30-degree field of view; optic disc at the center of the field; IOP (pneumatic tonometry): 12 mmHg; central corneal thickness: 500 µm; undilated pupil:
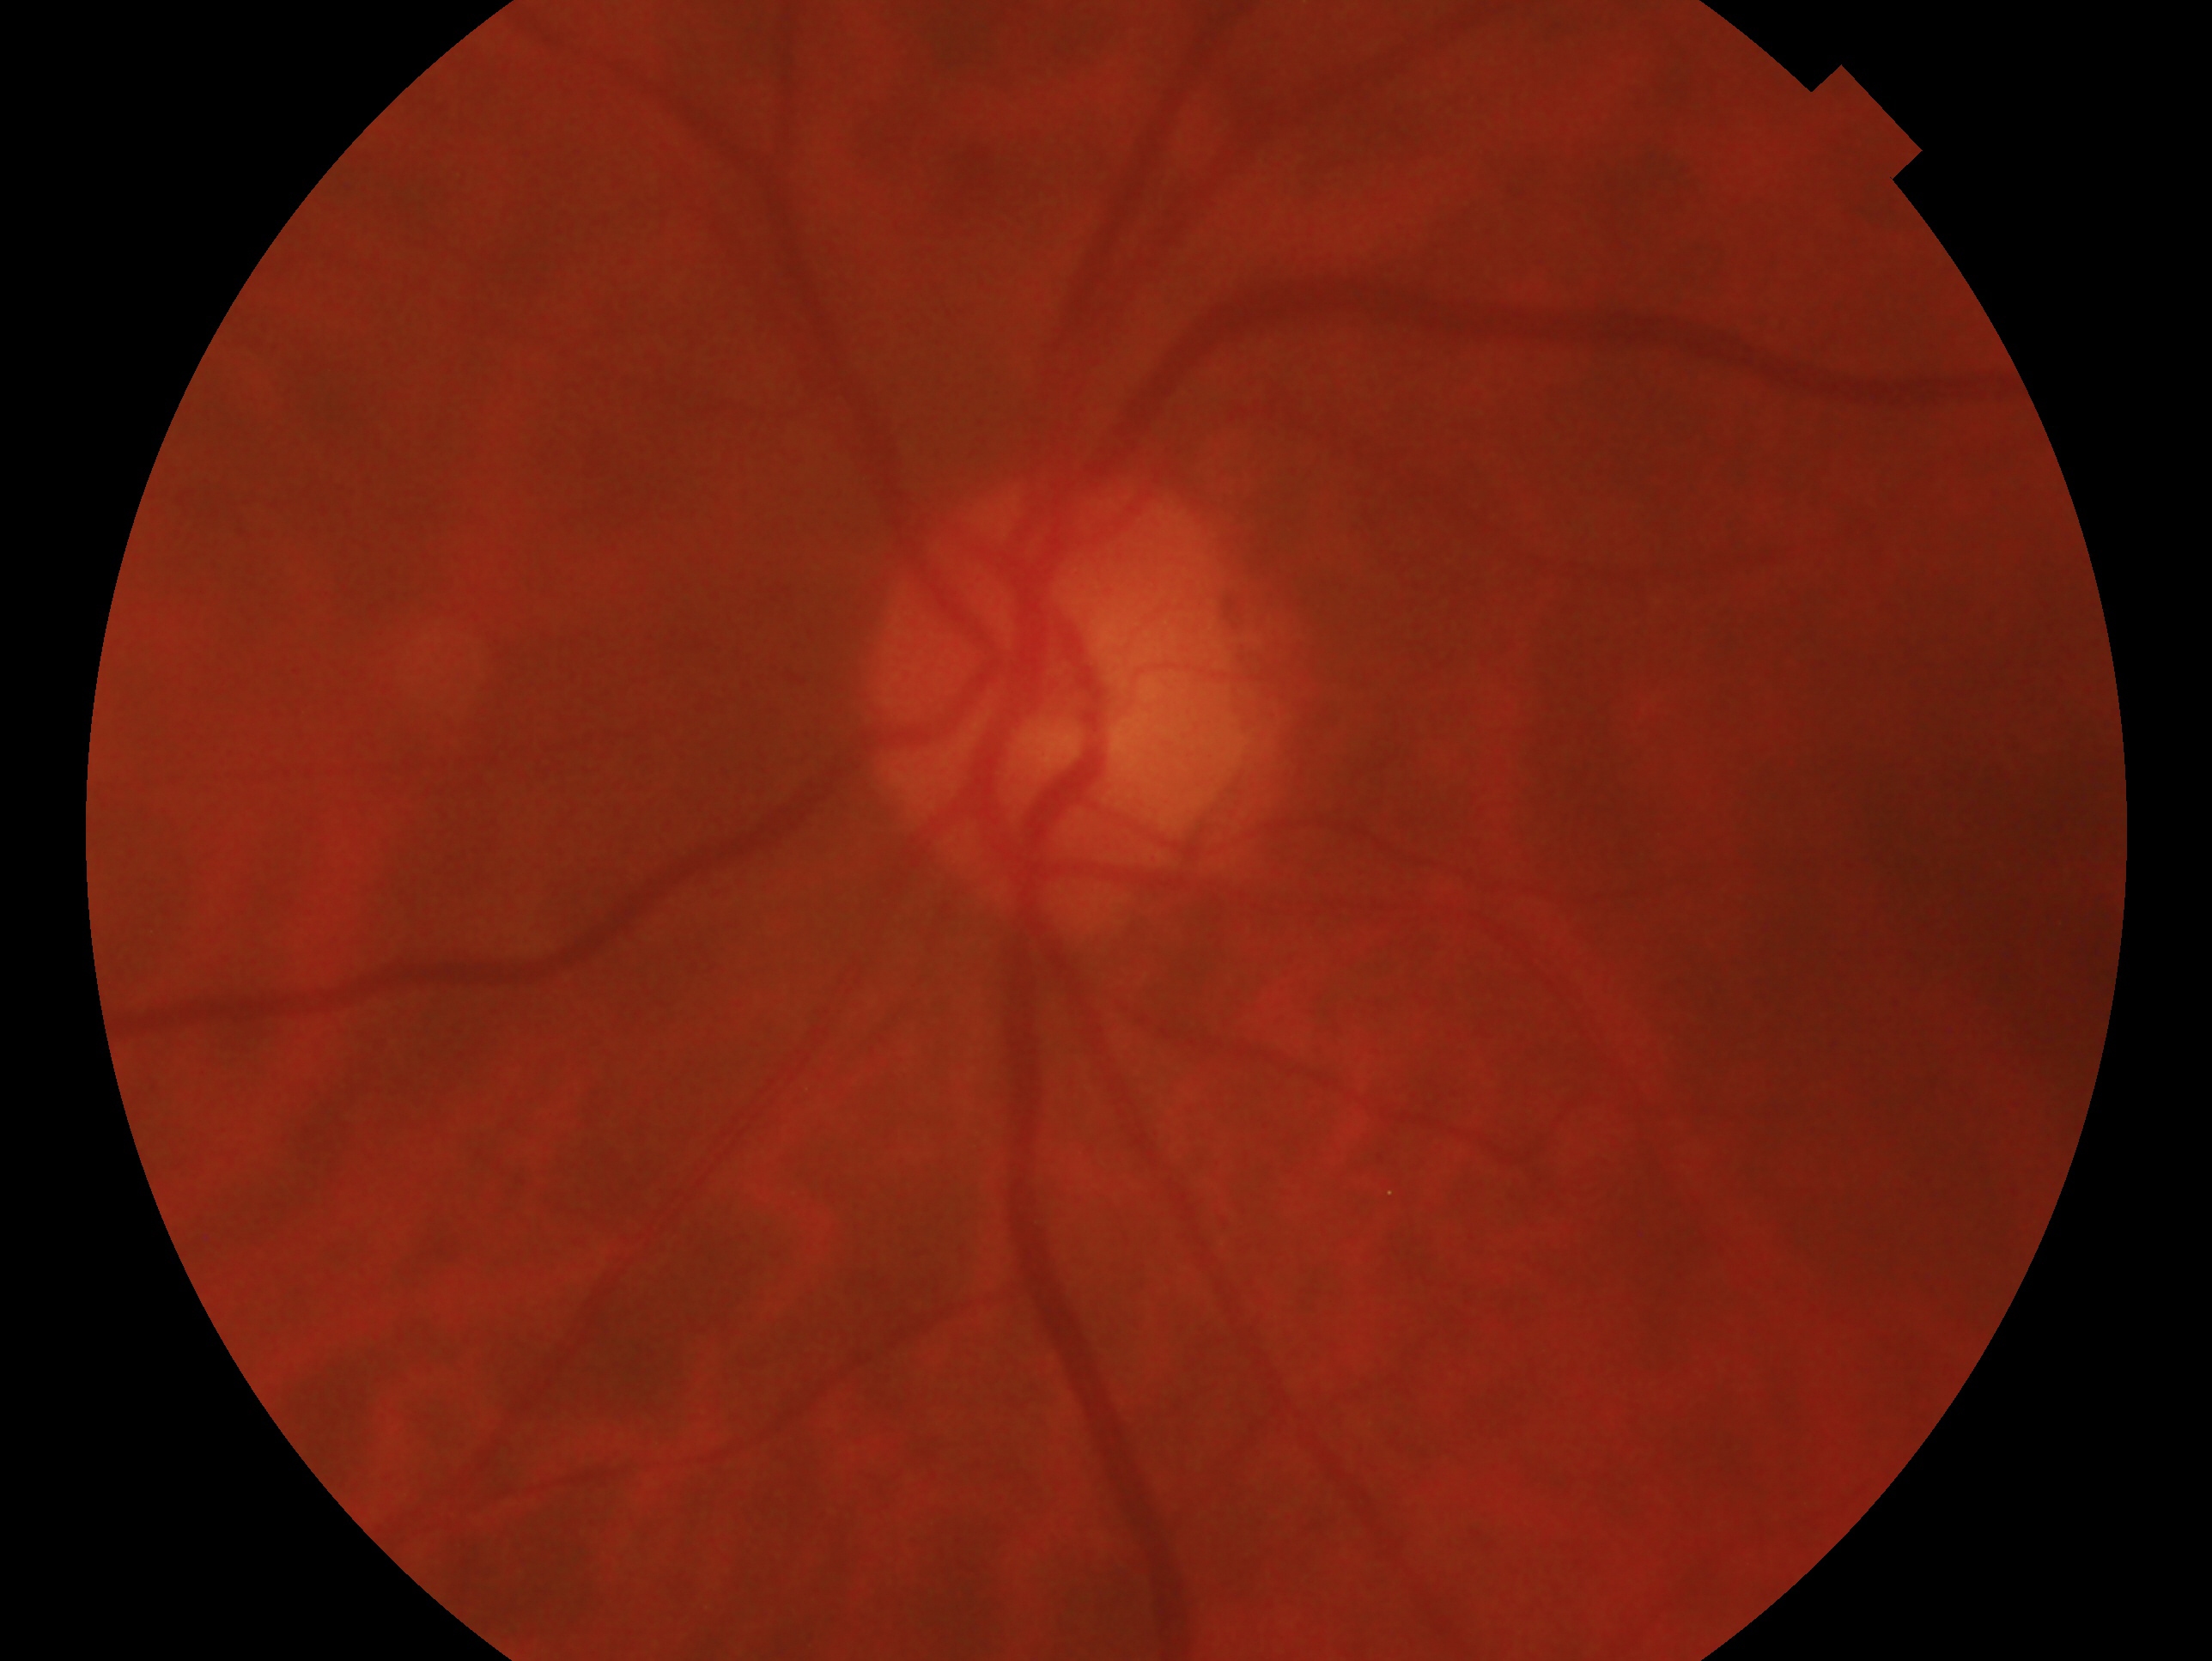

laterality = left eye
clinical classification = negative for glaucoma